Topcon TRC-50DX — 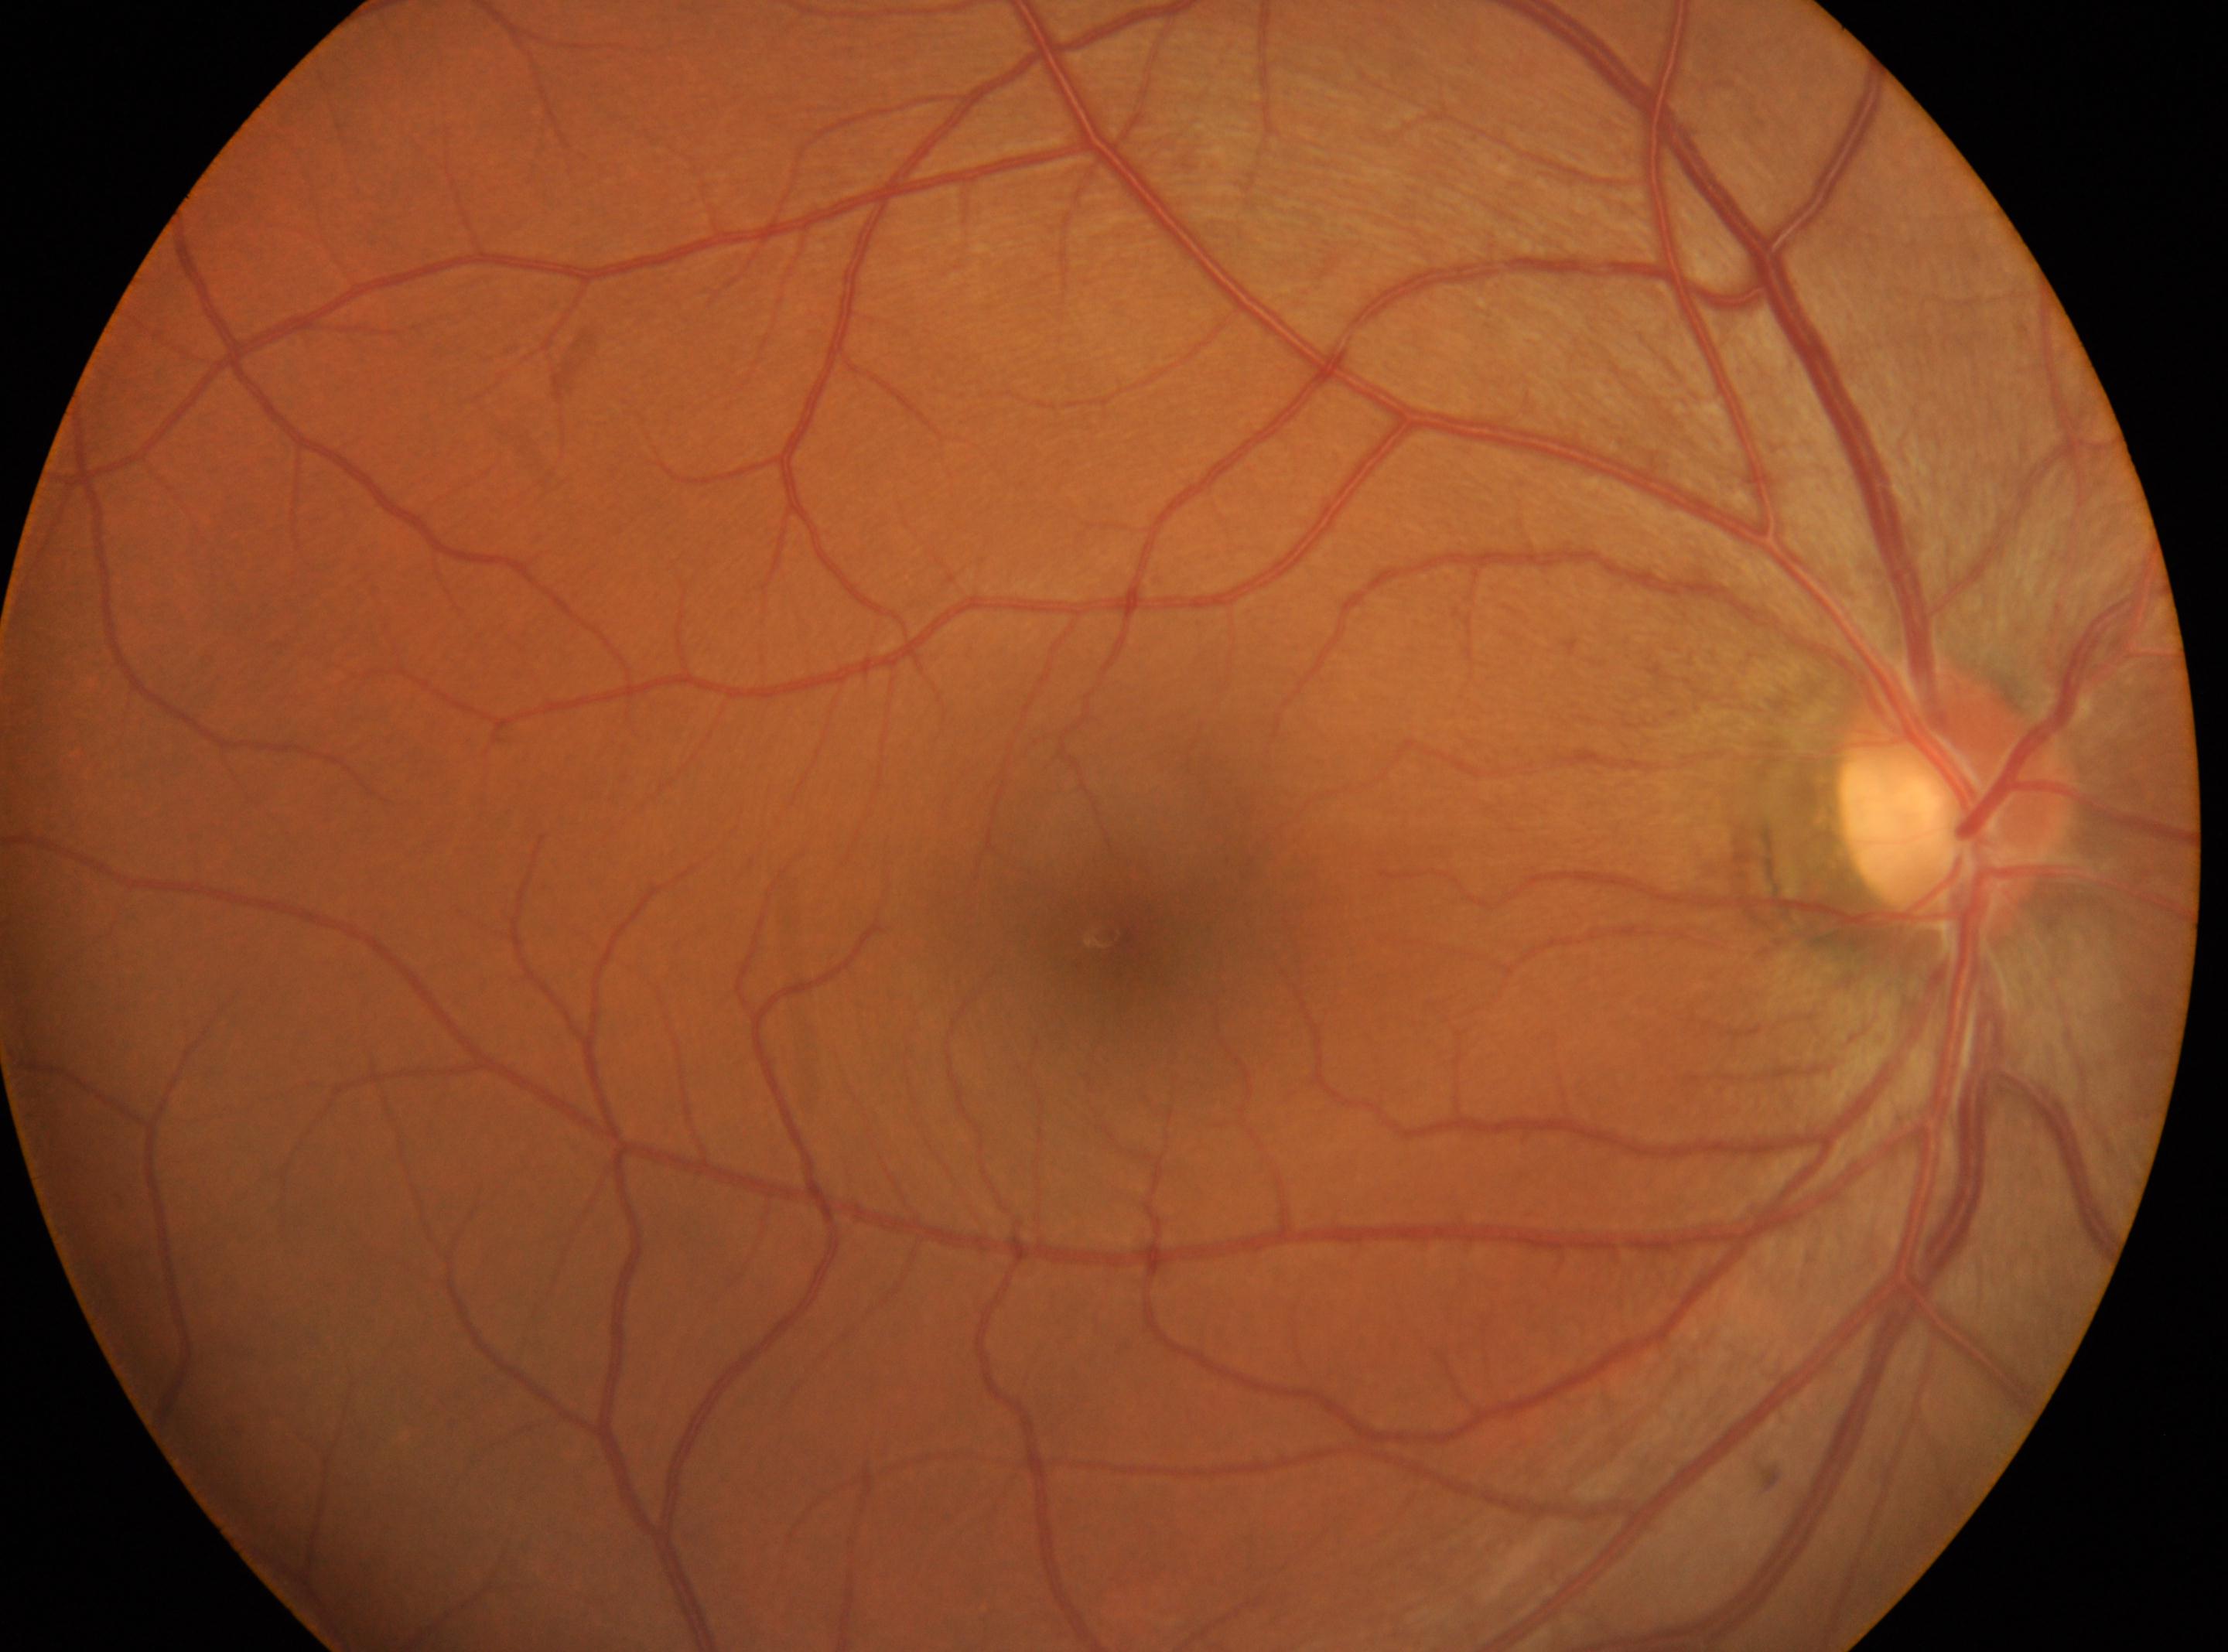

laterality = right | diabetic retinopathy (DR) = no apparent retinopathy (grade 0) | foveal center = 1105, 934 | ONH = 1951, 792.